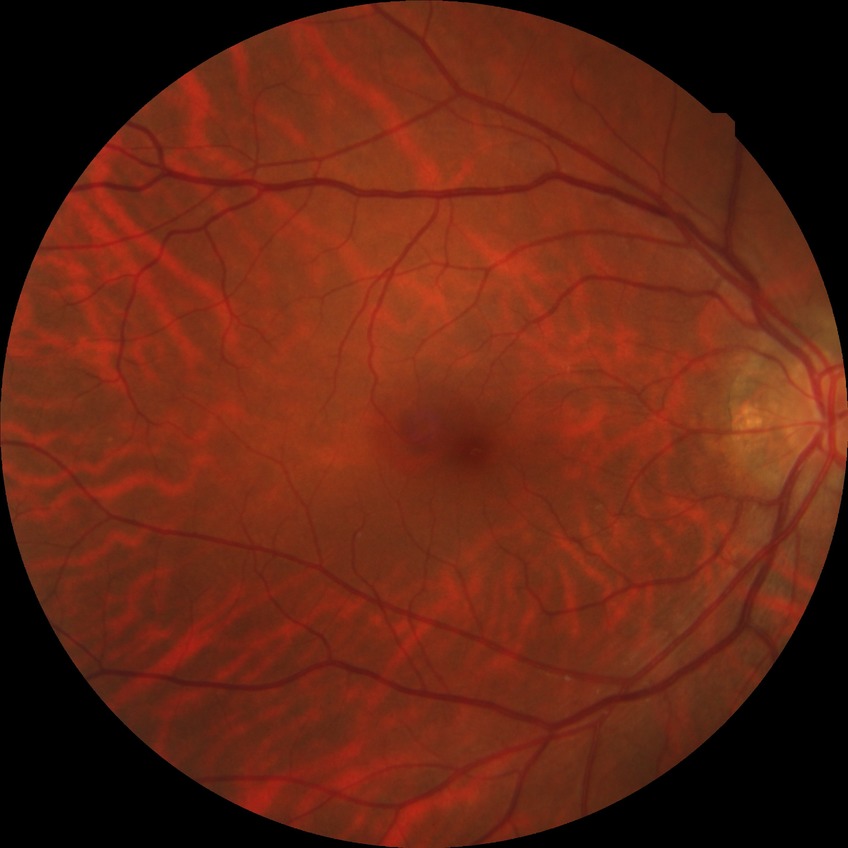 Davis grade: NDR; DR impression: no DR findings.